45° field of view. Color fundus image. 1380x1382px.
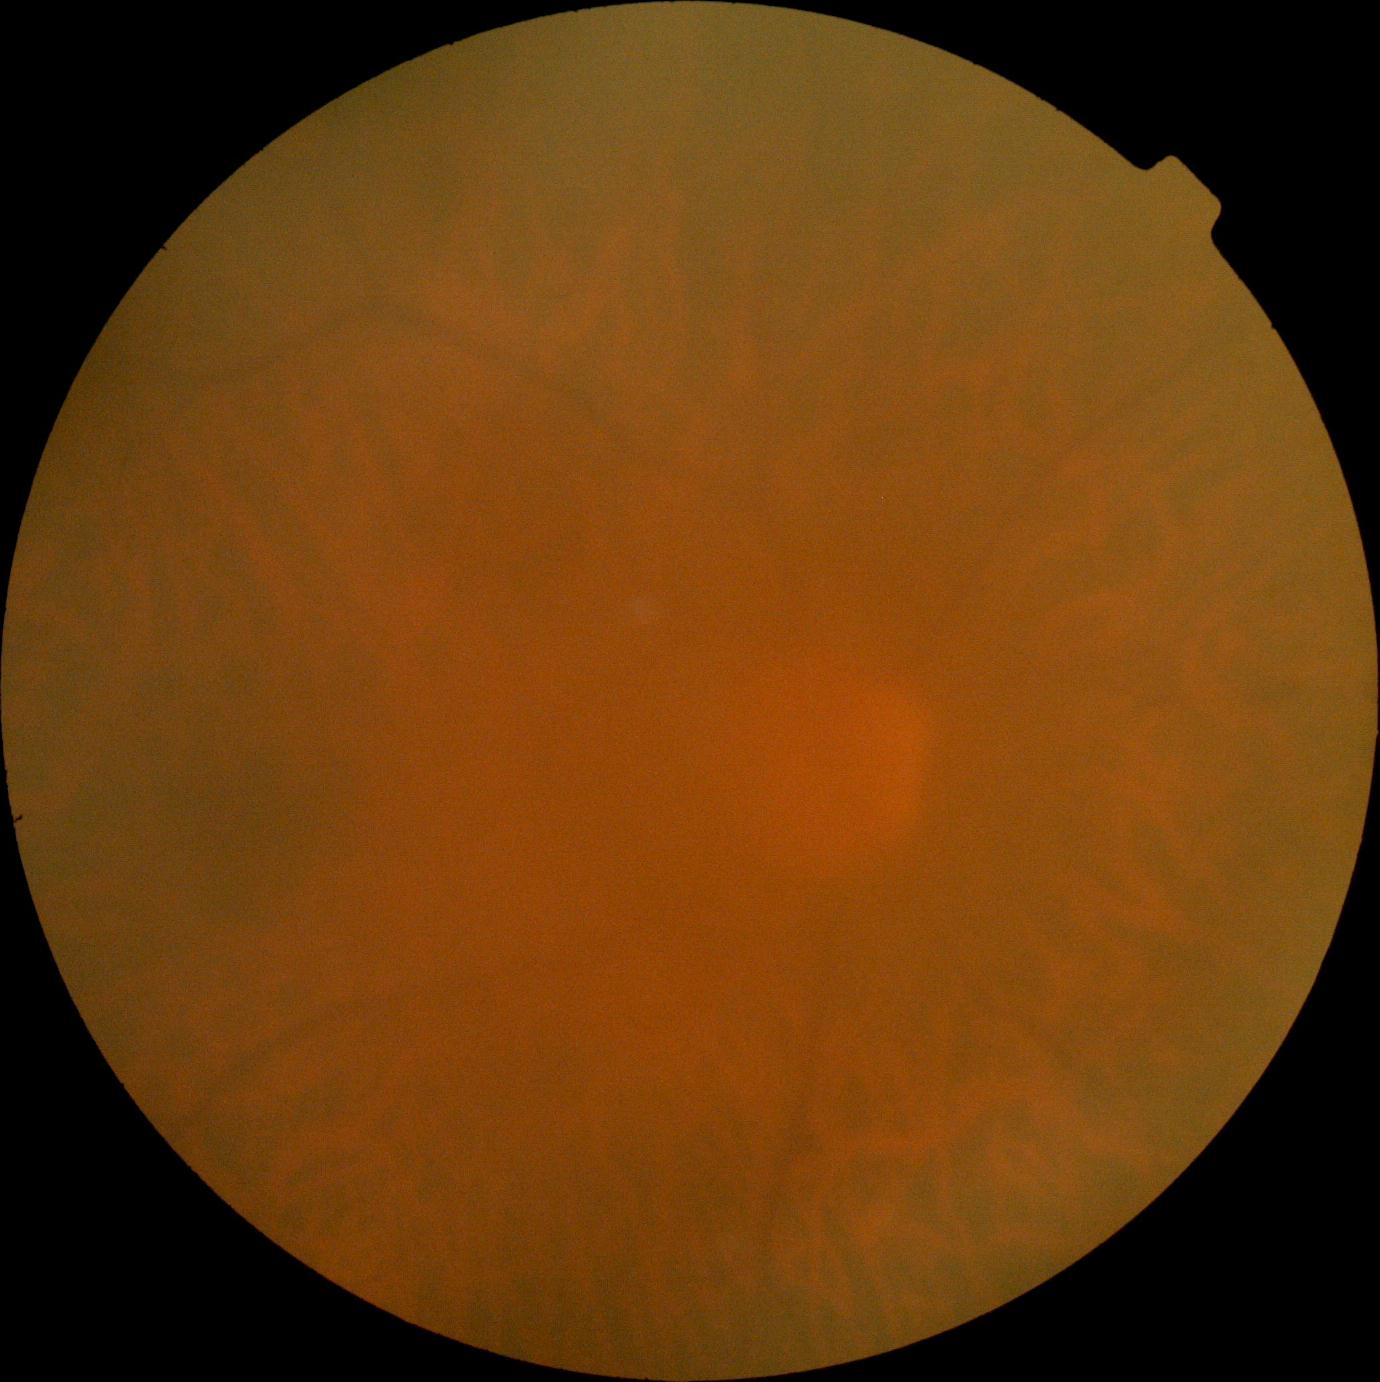

retinopathy: 0/4.